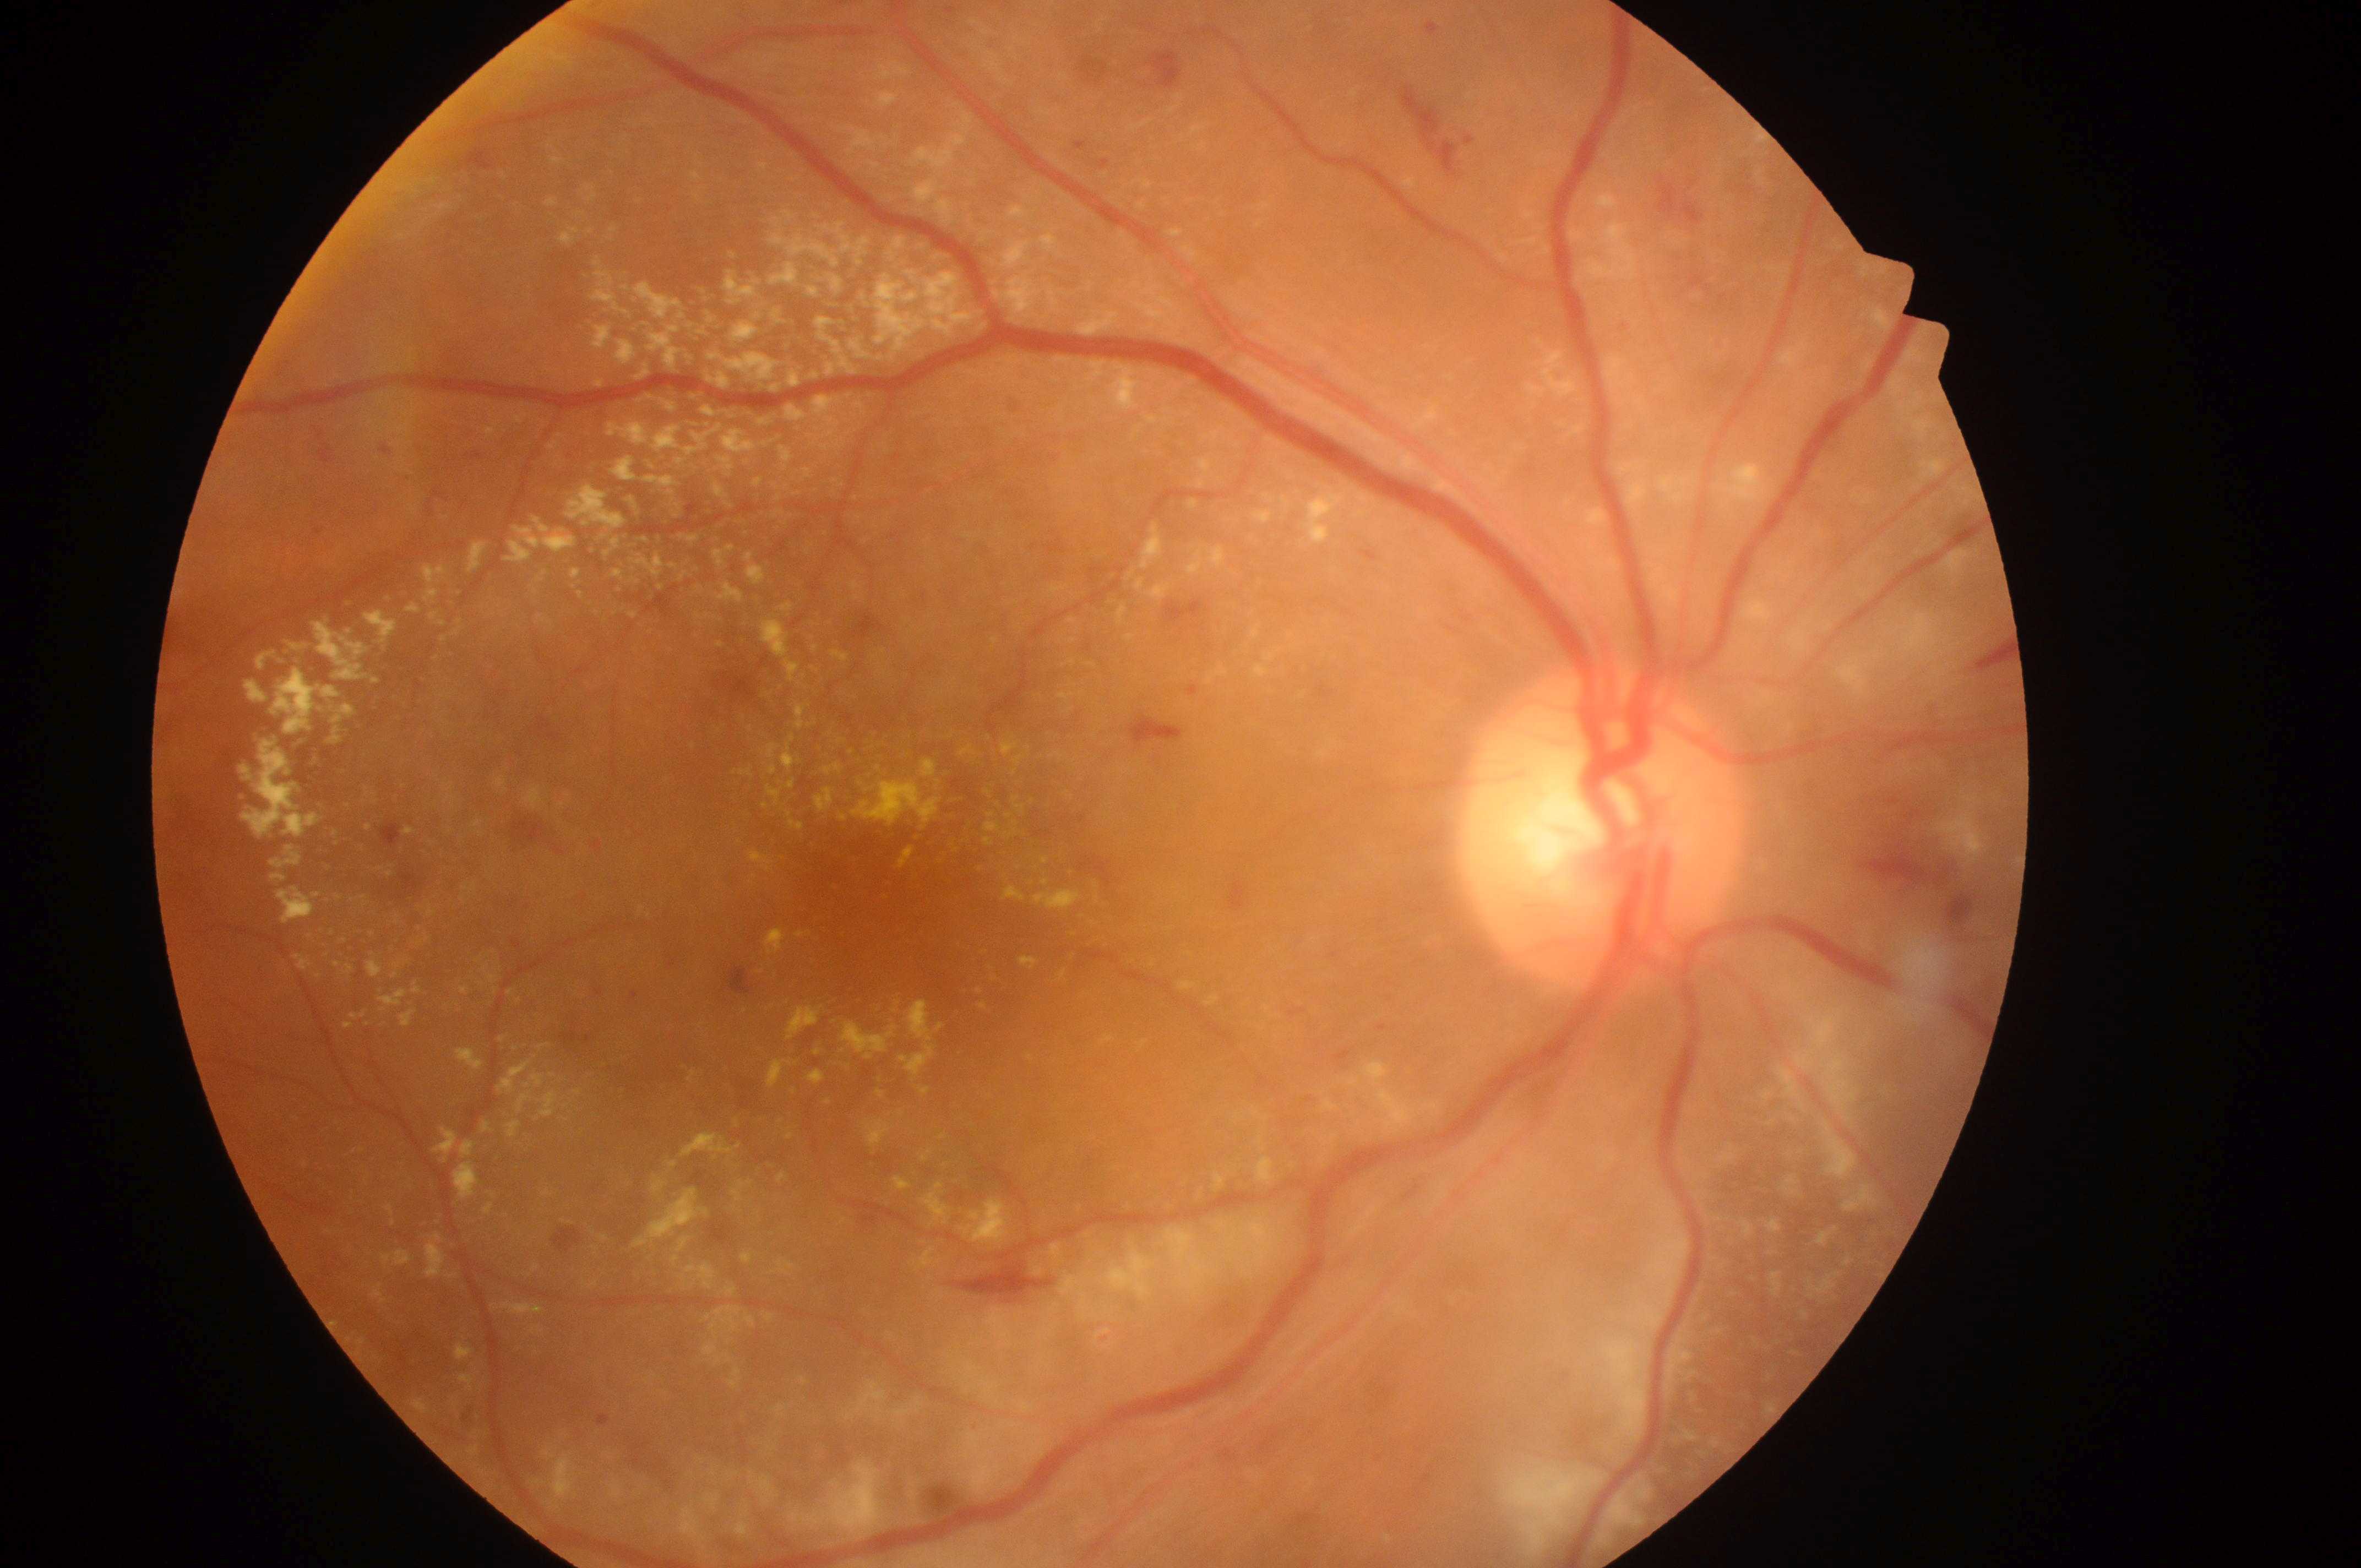
DR severity is grade 2 (moderate NPDR). ONH: (x=1601, y=847). DME risk: grade 2 (high risk). This is the oculus dexter. Fovea centralis: (x=924, y=919).